NIDEK AFC-230. Modified Davis classification. Nonmydriatic
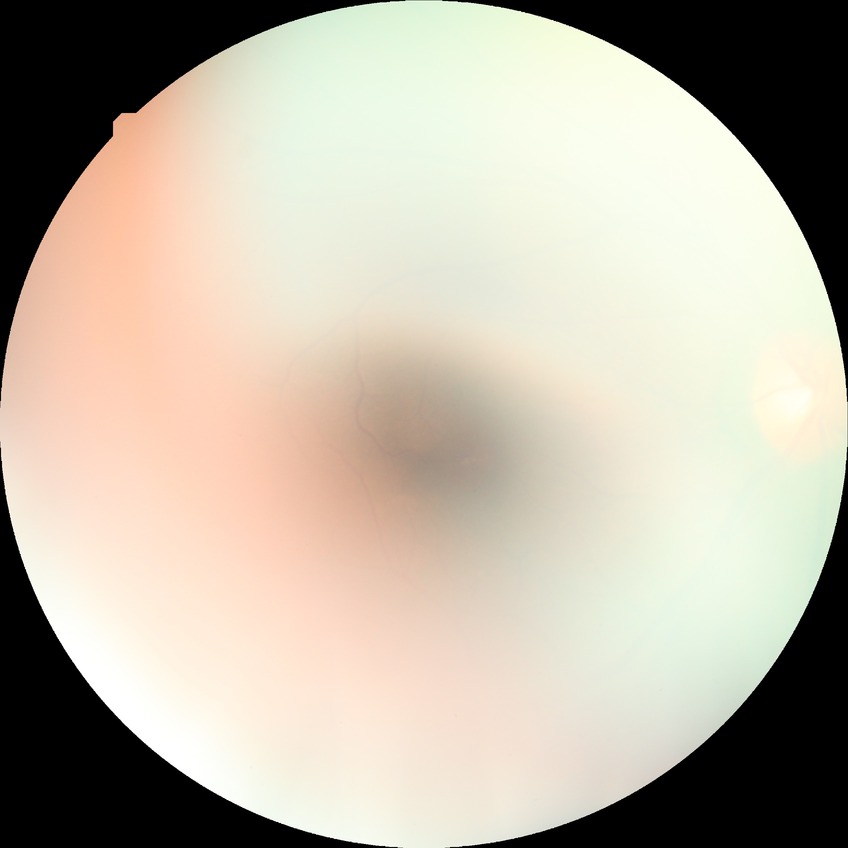 diabetic retinopathy (DR) = NDR (no diabetic retinopathy).